Camera: NIDEK AFC-230; diabetic retinopathy graded by the modified Davis classification
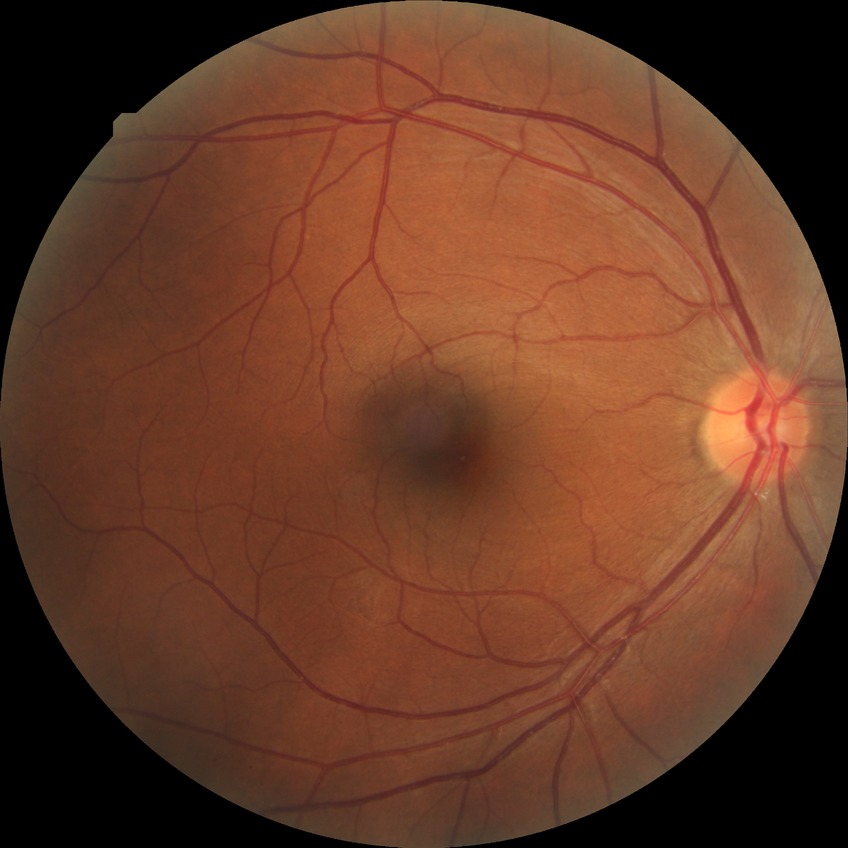

Retinopathy grade: no diabetic retinopathy.